DR severity per modified Davis staging.
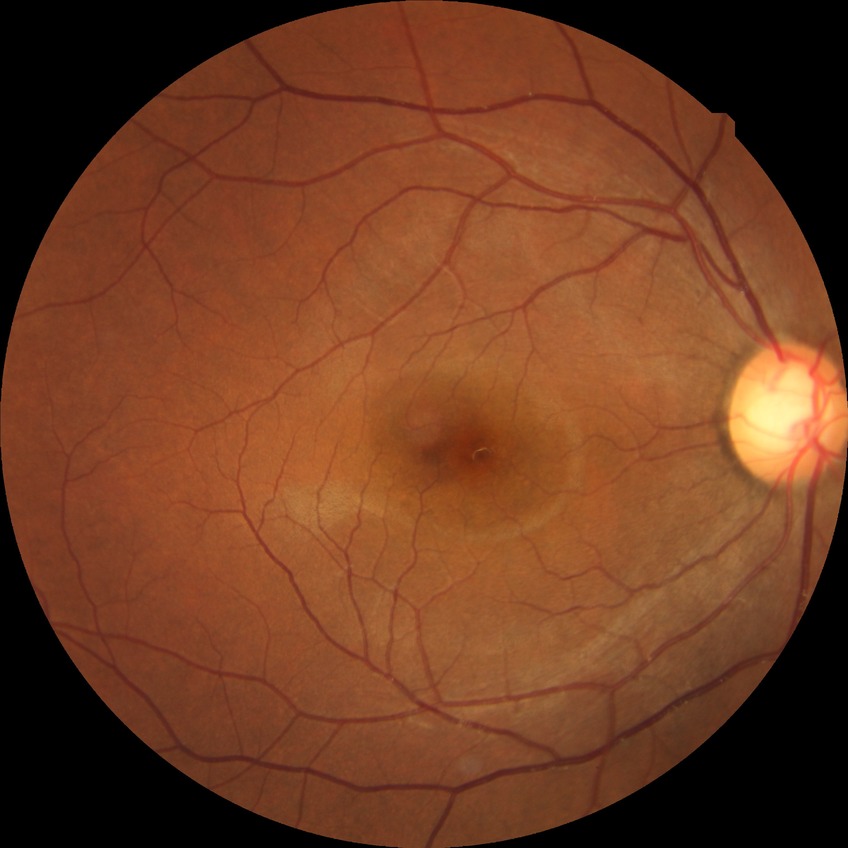

diabetic retinopathy (DR)@NDR (no diabetic retinopathy).